Tabletop color fundus camera image: 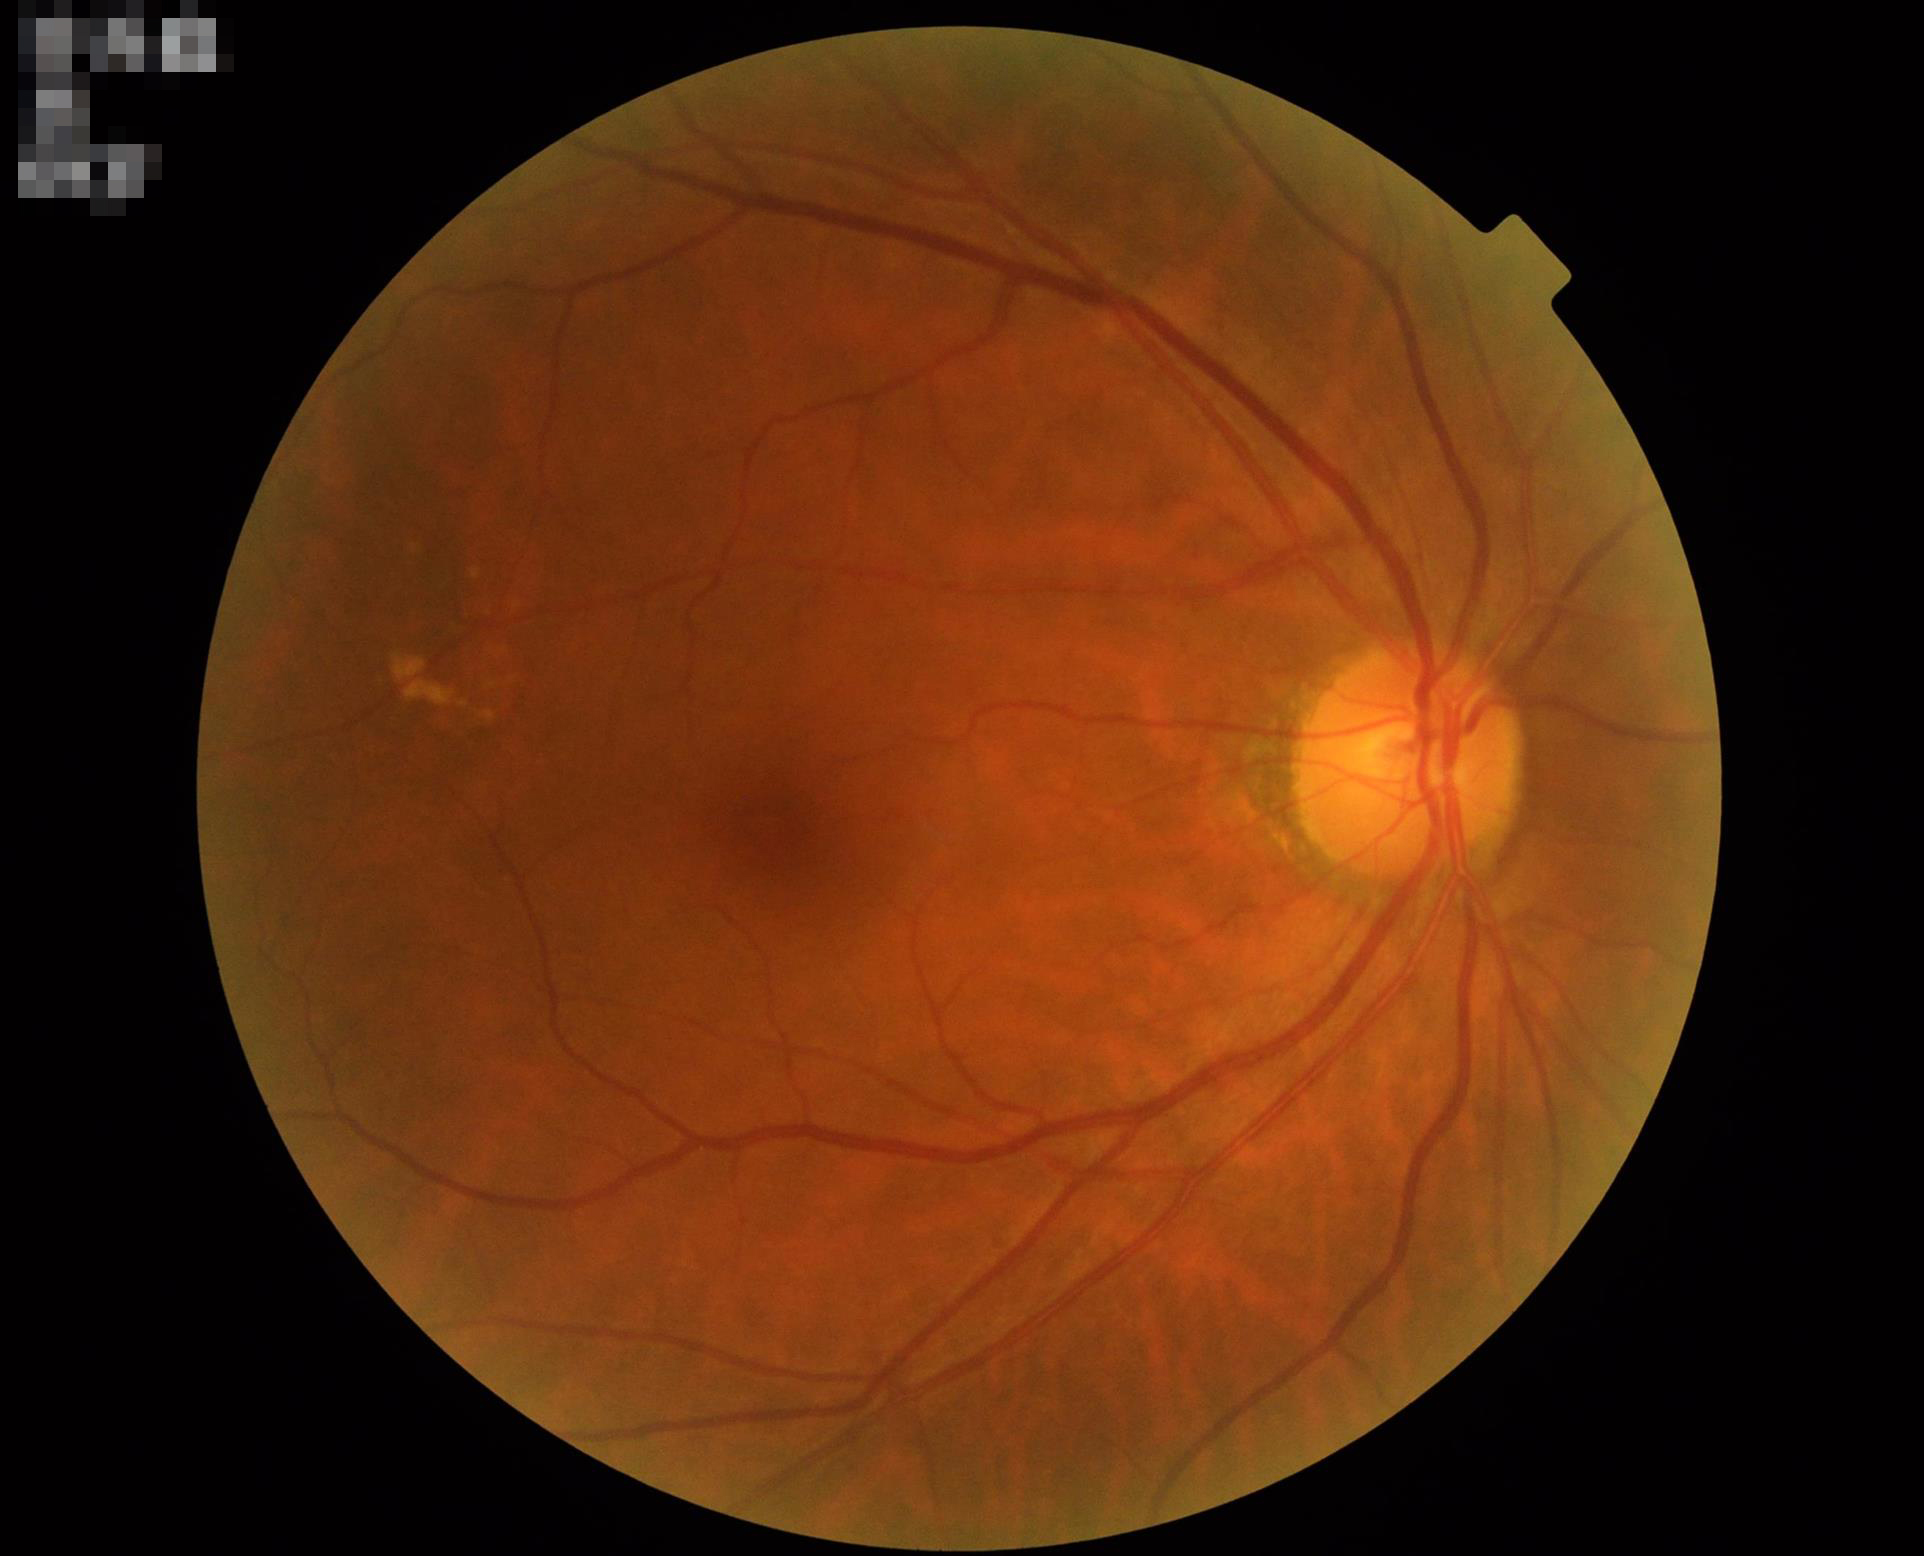
Adequate contrast for distinguishing structures. Overall quality is good and the image is gradable. Illumination is even.